Color fundus image — 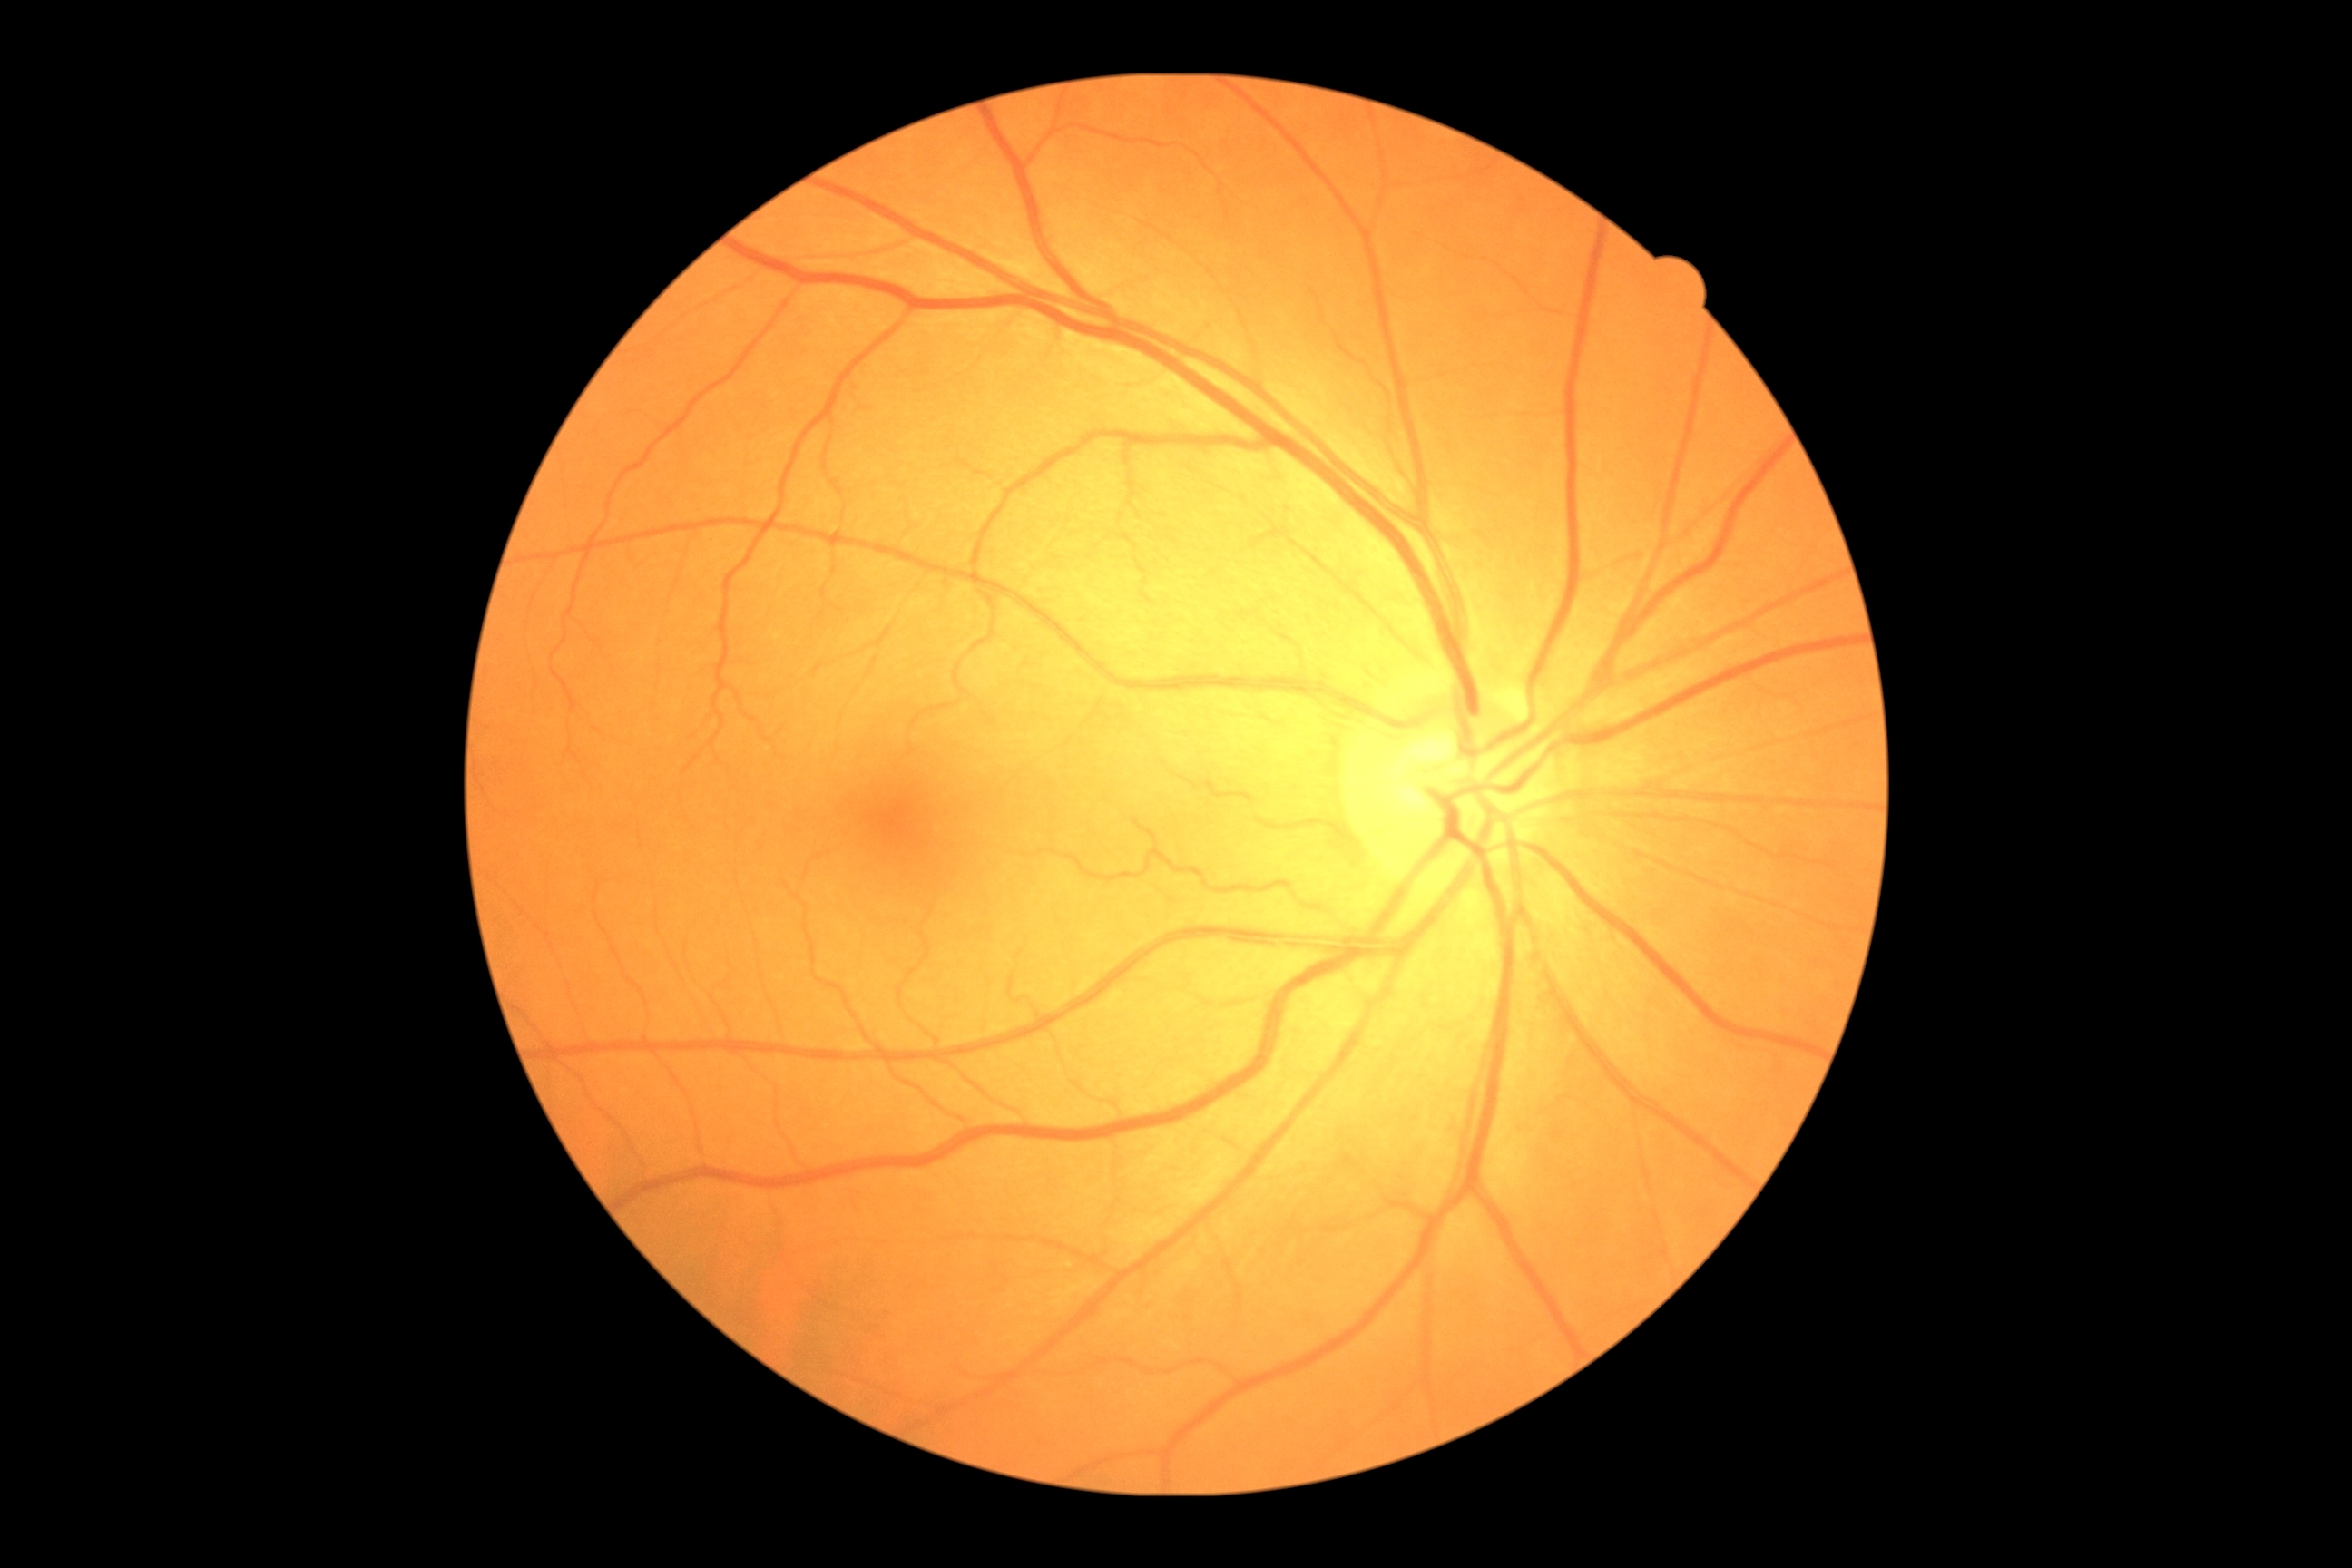 Annotations:
– DR impression — negative for DR
– DR grade — 0 — no visible signs of diabetic retinopathy